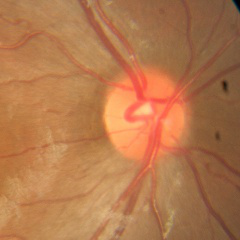
Q: Does this eye have glaucoma?
A: No — no evidence of glaucoma.